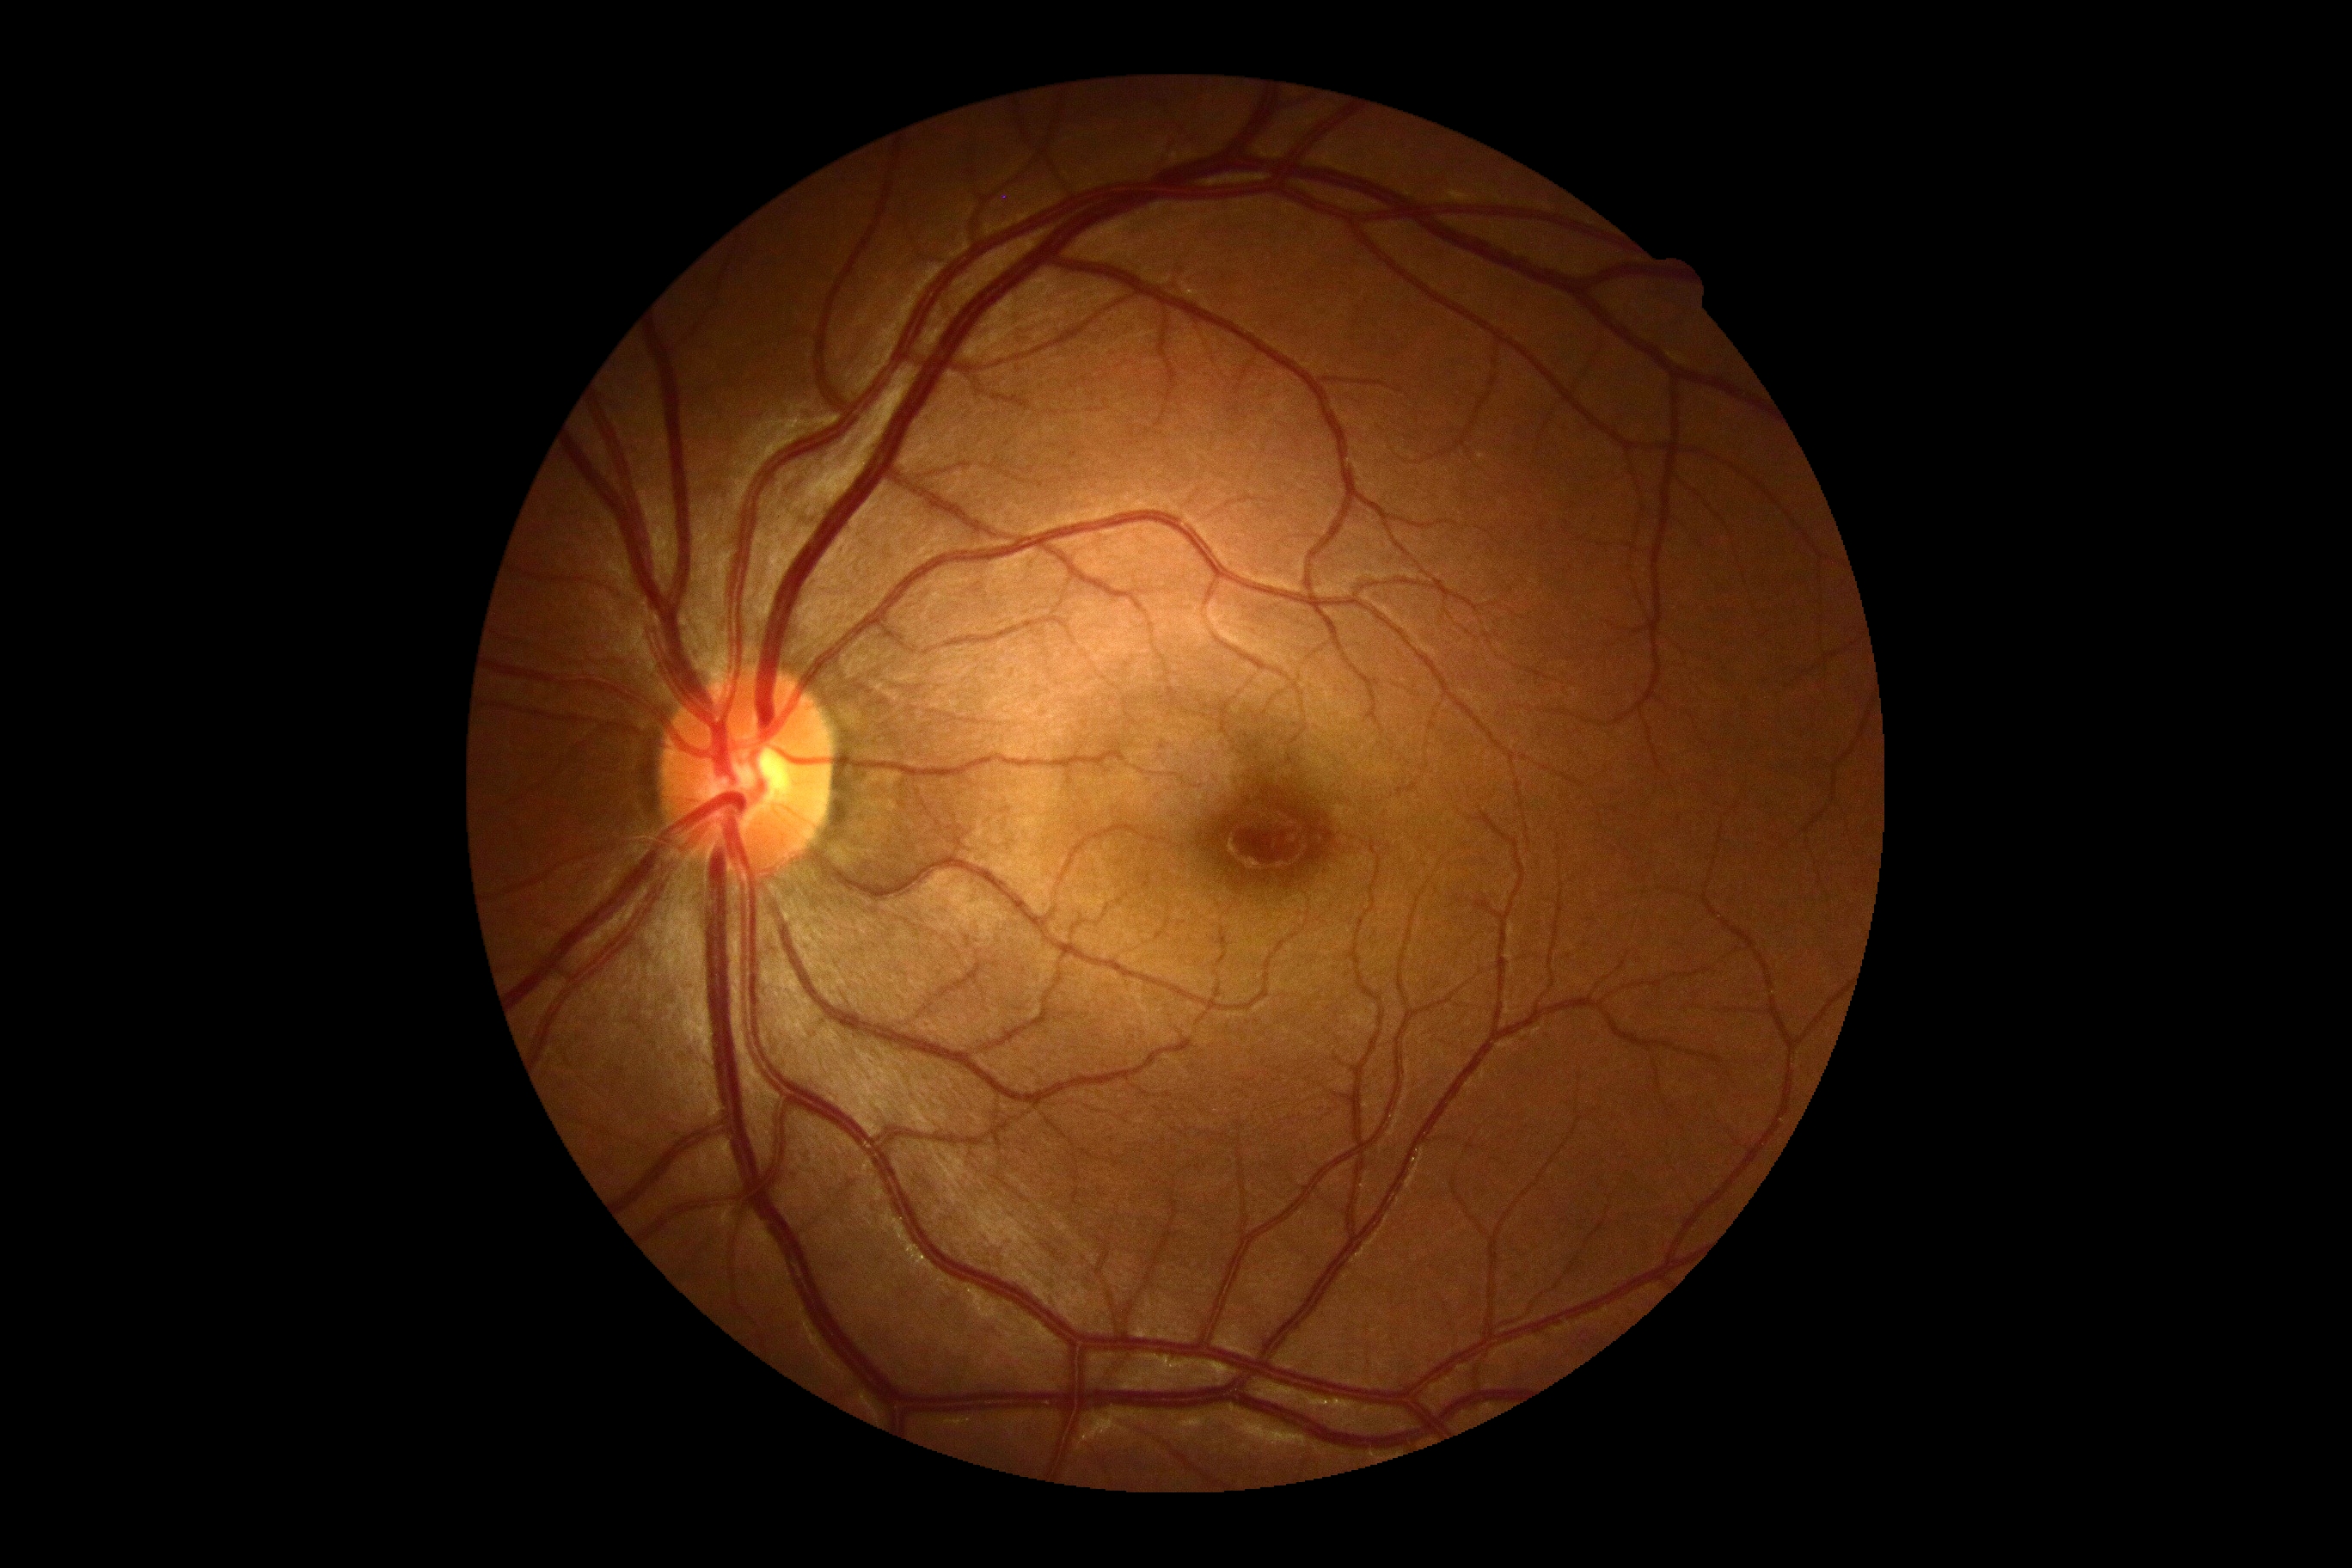 Findings:
- diabetic retinopathy (DR) — 0 — no visible signs of diabetic retinopathy